Without pupil dilation, DR severity per modified Davis staging — 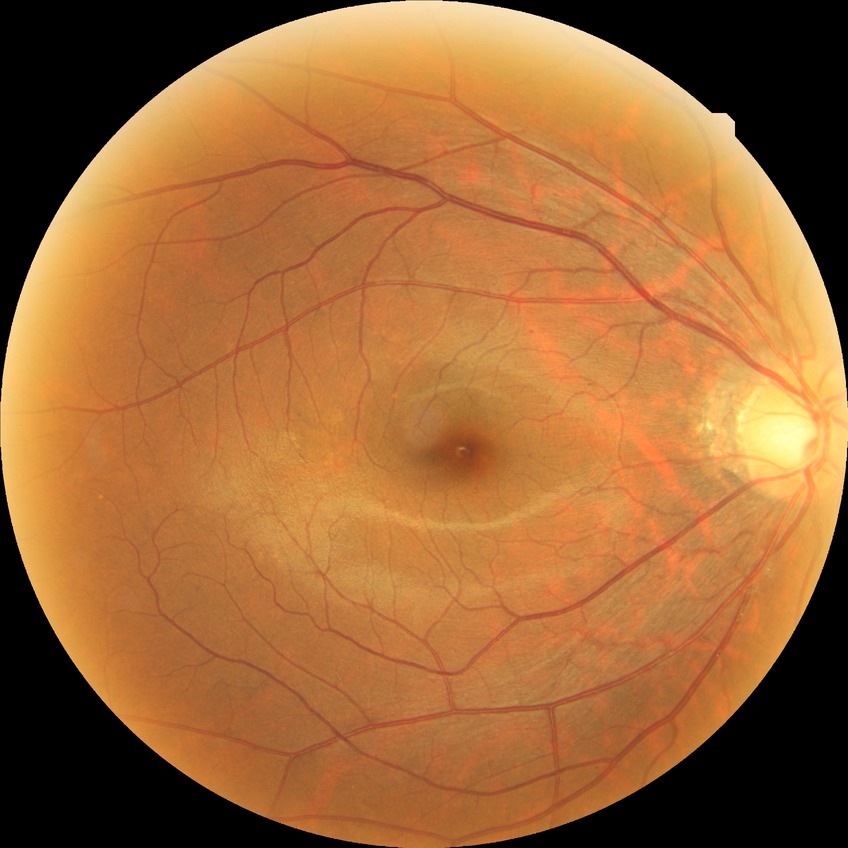 Retinopathy grade is simple diabetic retinopathy. DR class: non-proliferative diabetic retinopathy.